No pharmacologic dilation. Posterior pole color fundus photograph.
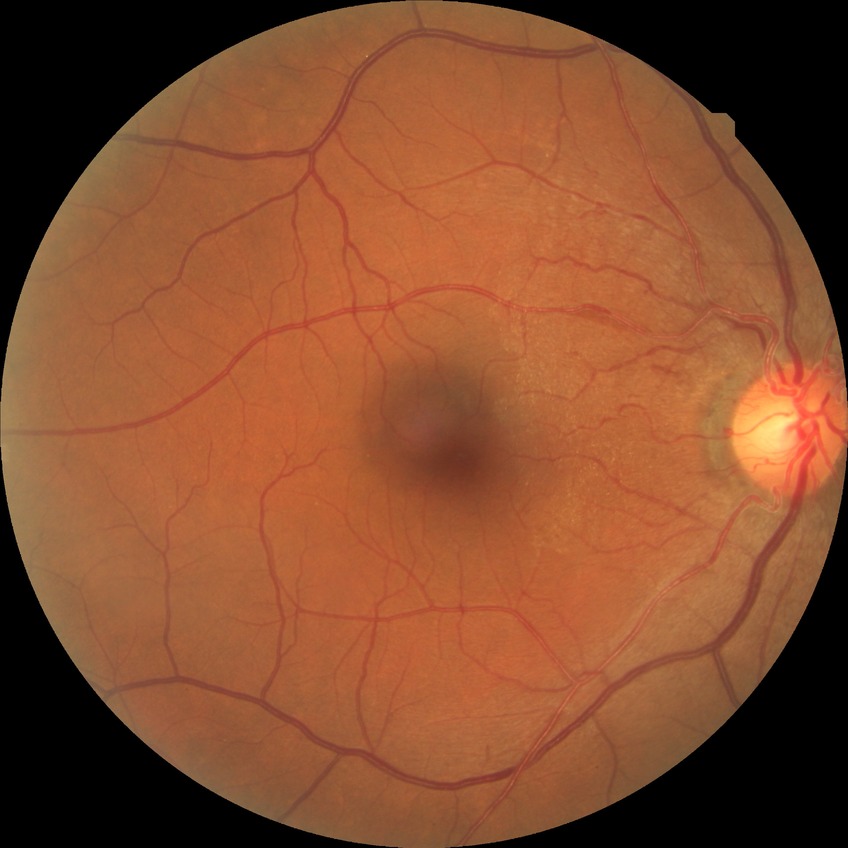 Retinopathy grade is simple diabetic retinopathy.